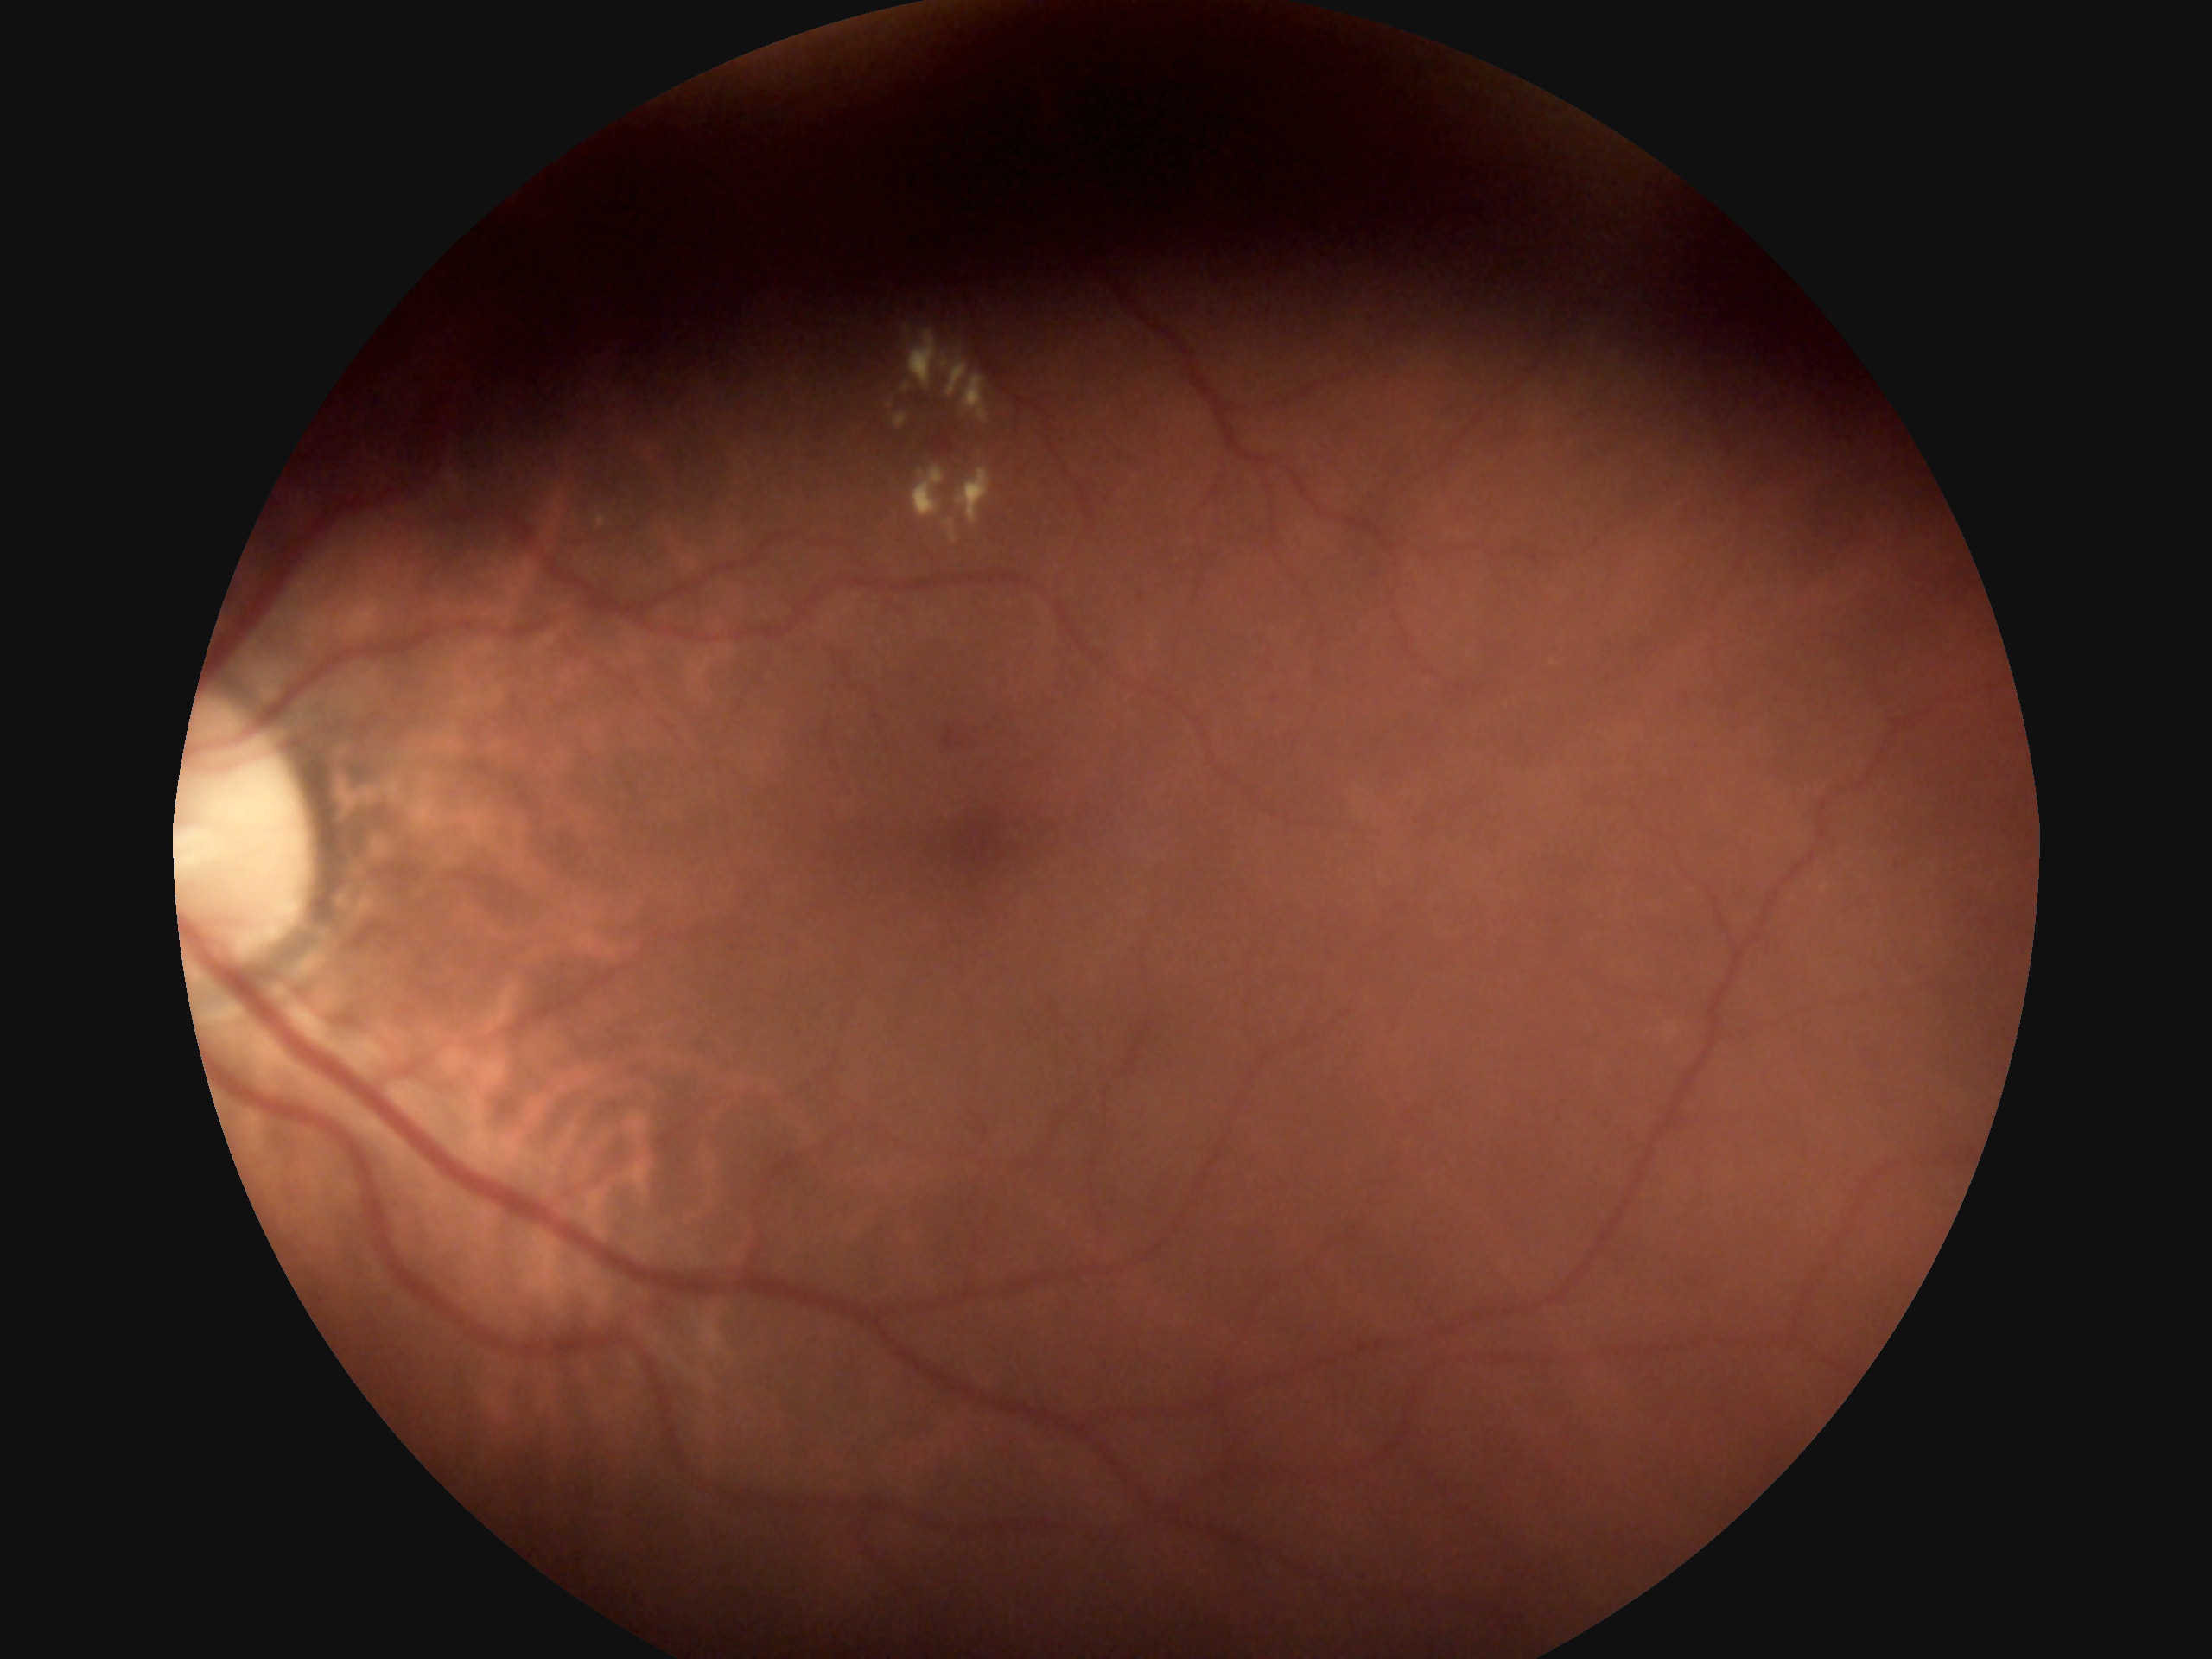
Retinopathy: grade 2 (moderate NPDR).